Non-mydriatic fundus camera — 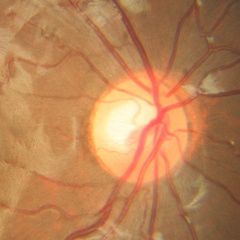
Glaucoma status: no evidence of glaucoma.